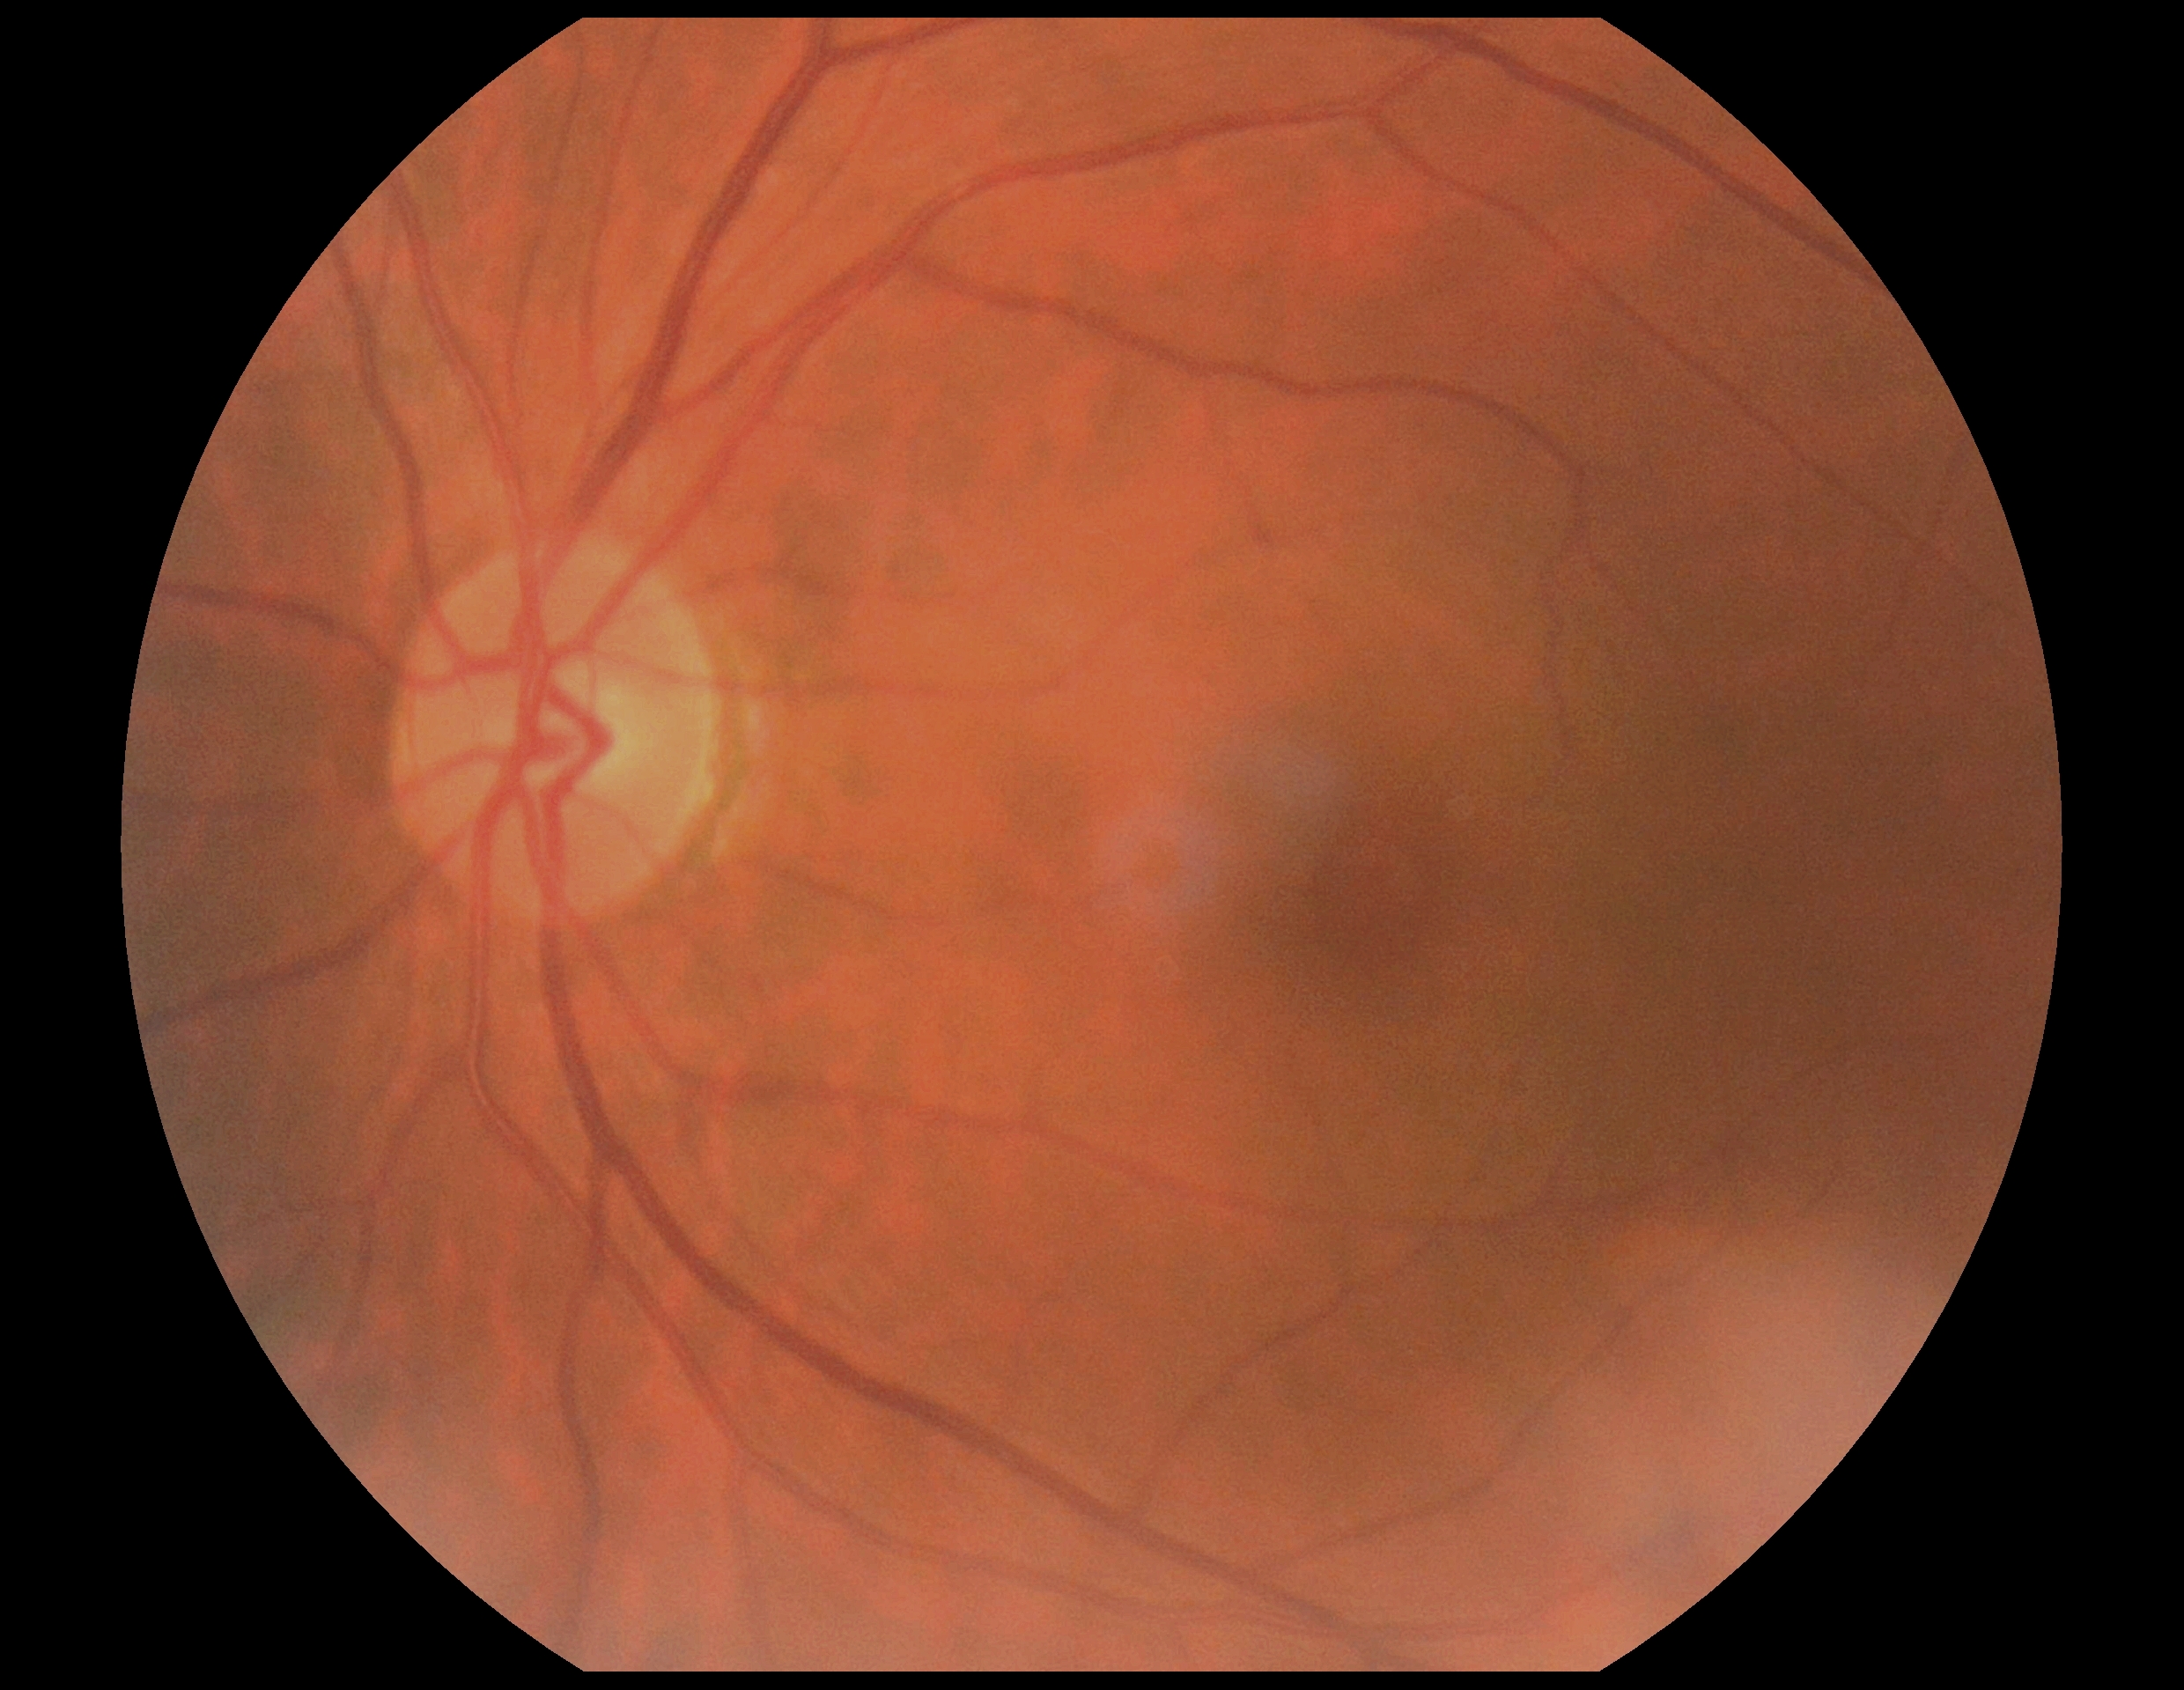 Diabetic retinopathy (DR) is 0/4 — no visible signs of diabetic retinopathy. No diabetic retinal disease findings.